Captured with the Clarity RetCam 3 (130° field of view); 640 x 480 pixels; wide-field fundus image from infant ROP screening: 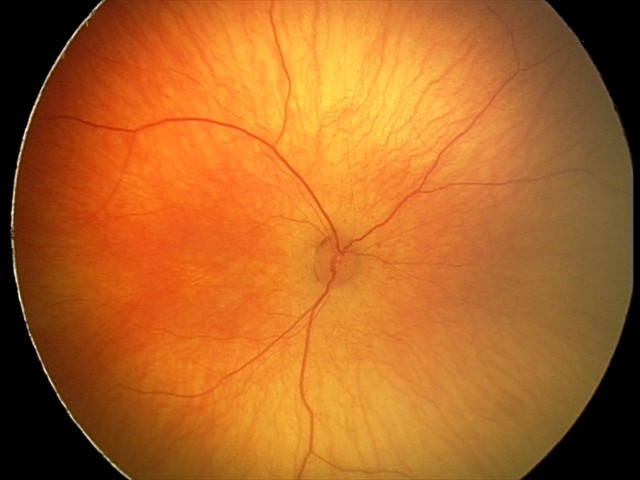

Screening examination diagnosed as physiological.